1240 x 1240 pixels · wide-field contact fundus photograph of an infant.
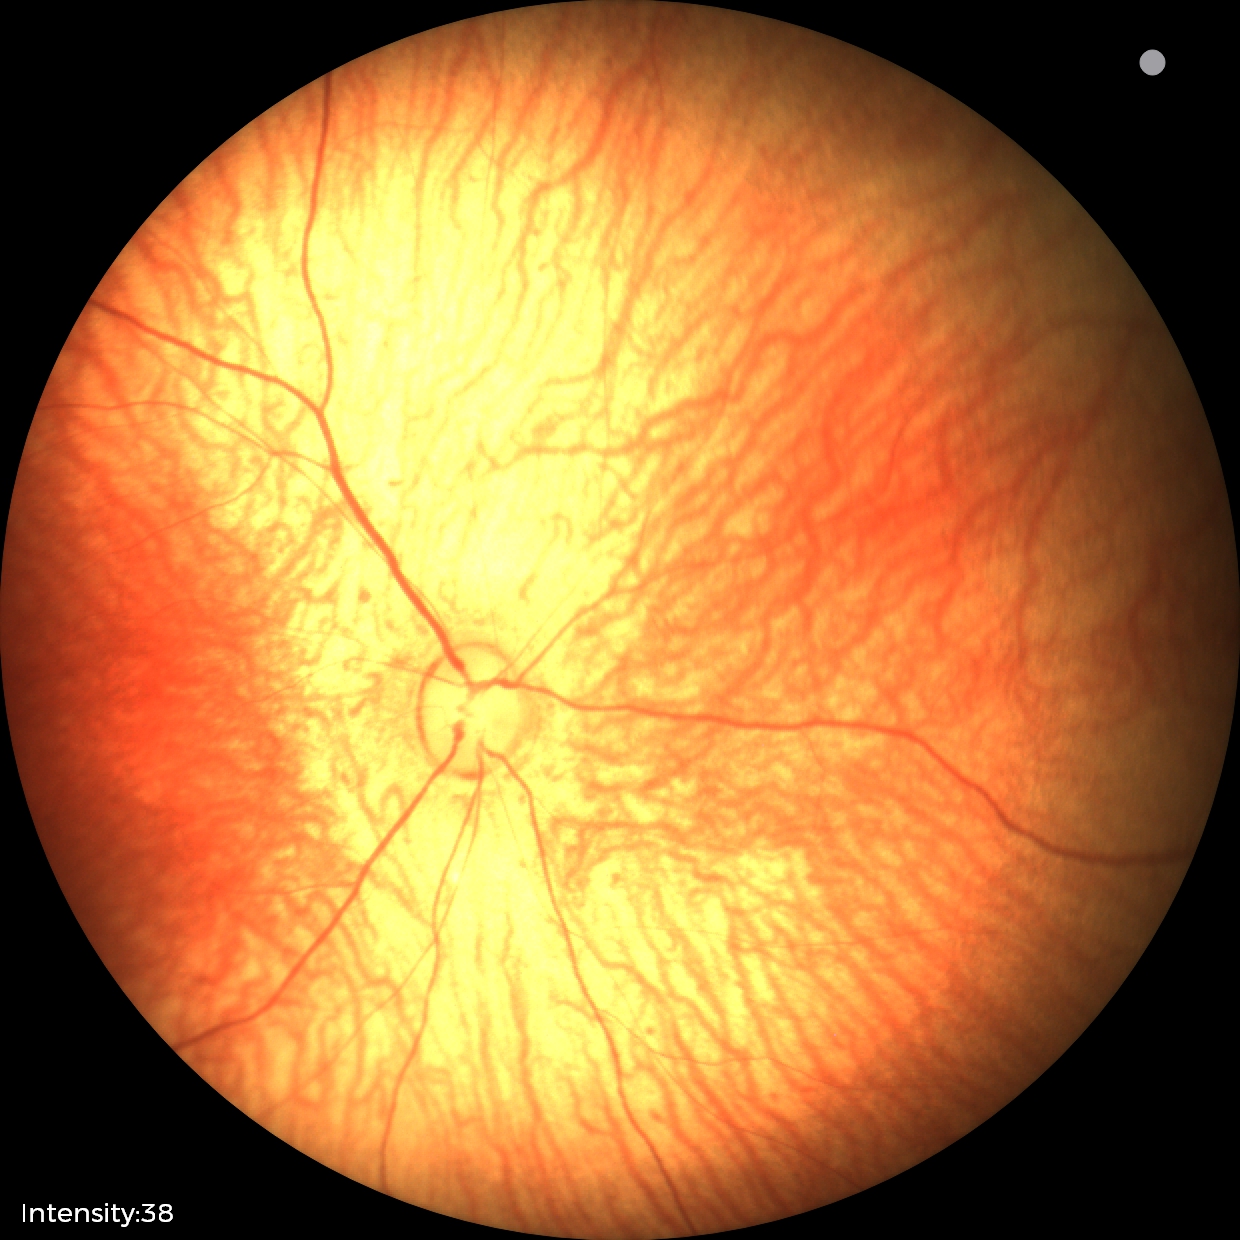

Screening examination with no abnormal retinal findings.